Optic nerve head photograph — 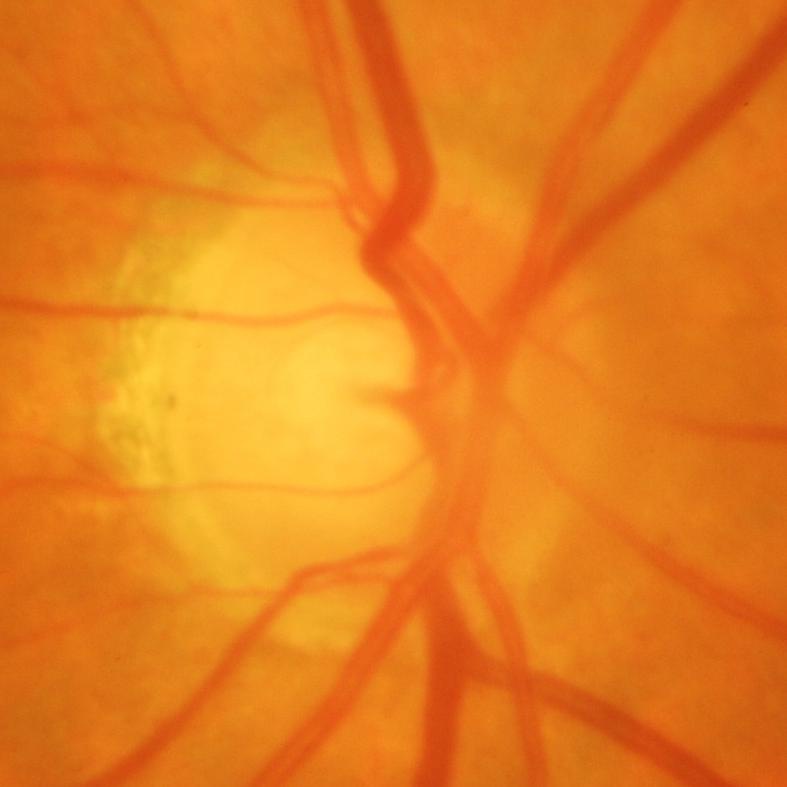 Glaucoma is present. Glaucoma diagnosis: glaucomatous damage to the optic nerve.